2048 by 1536 pixels — 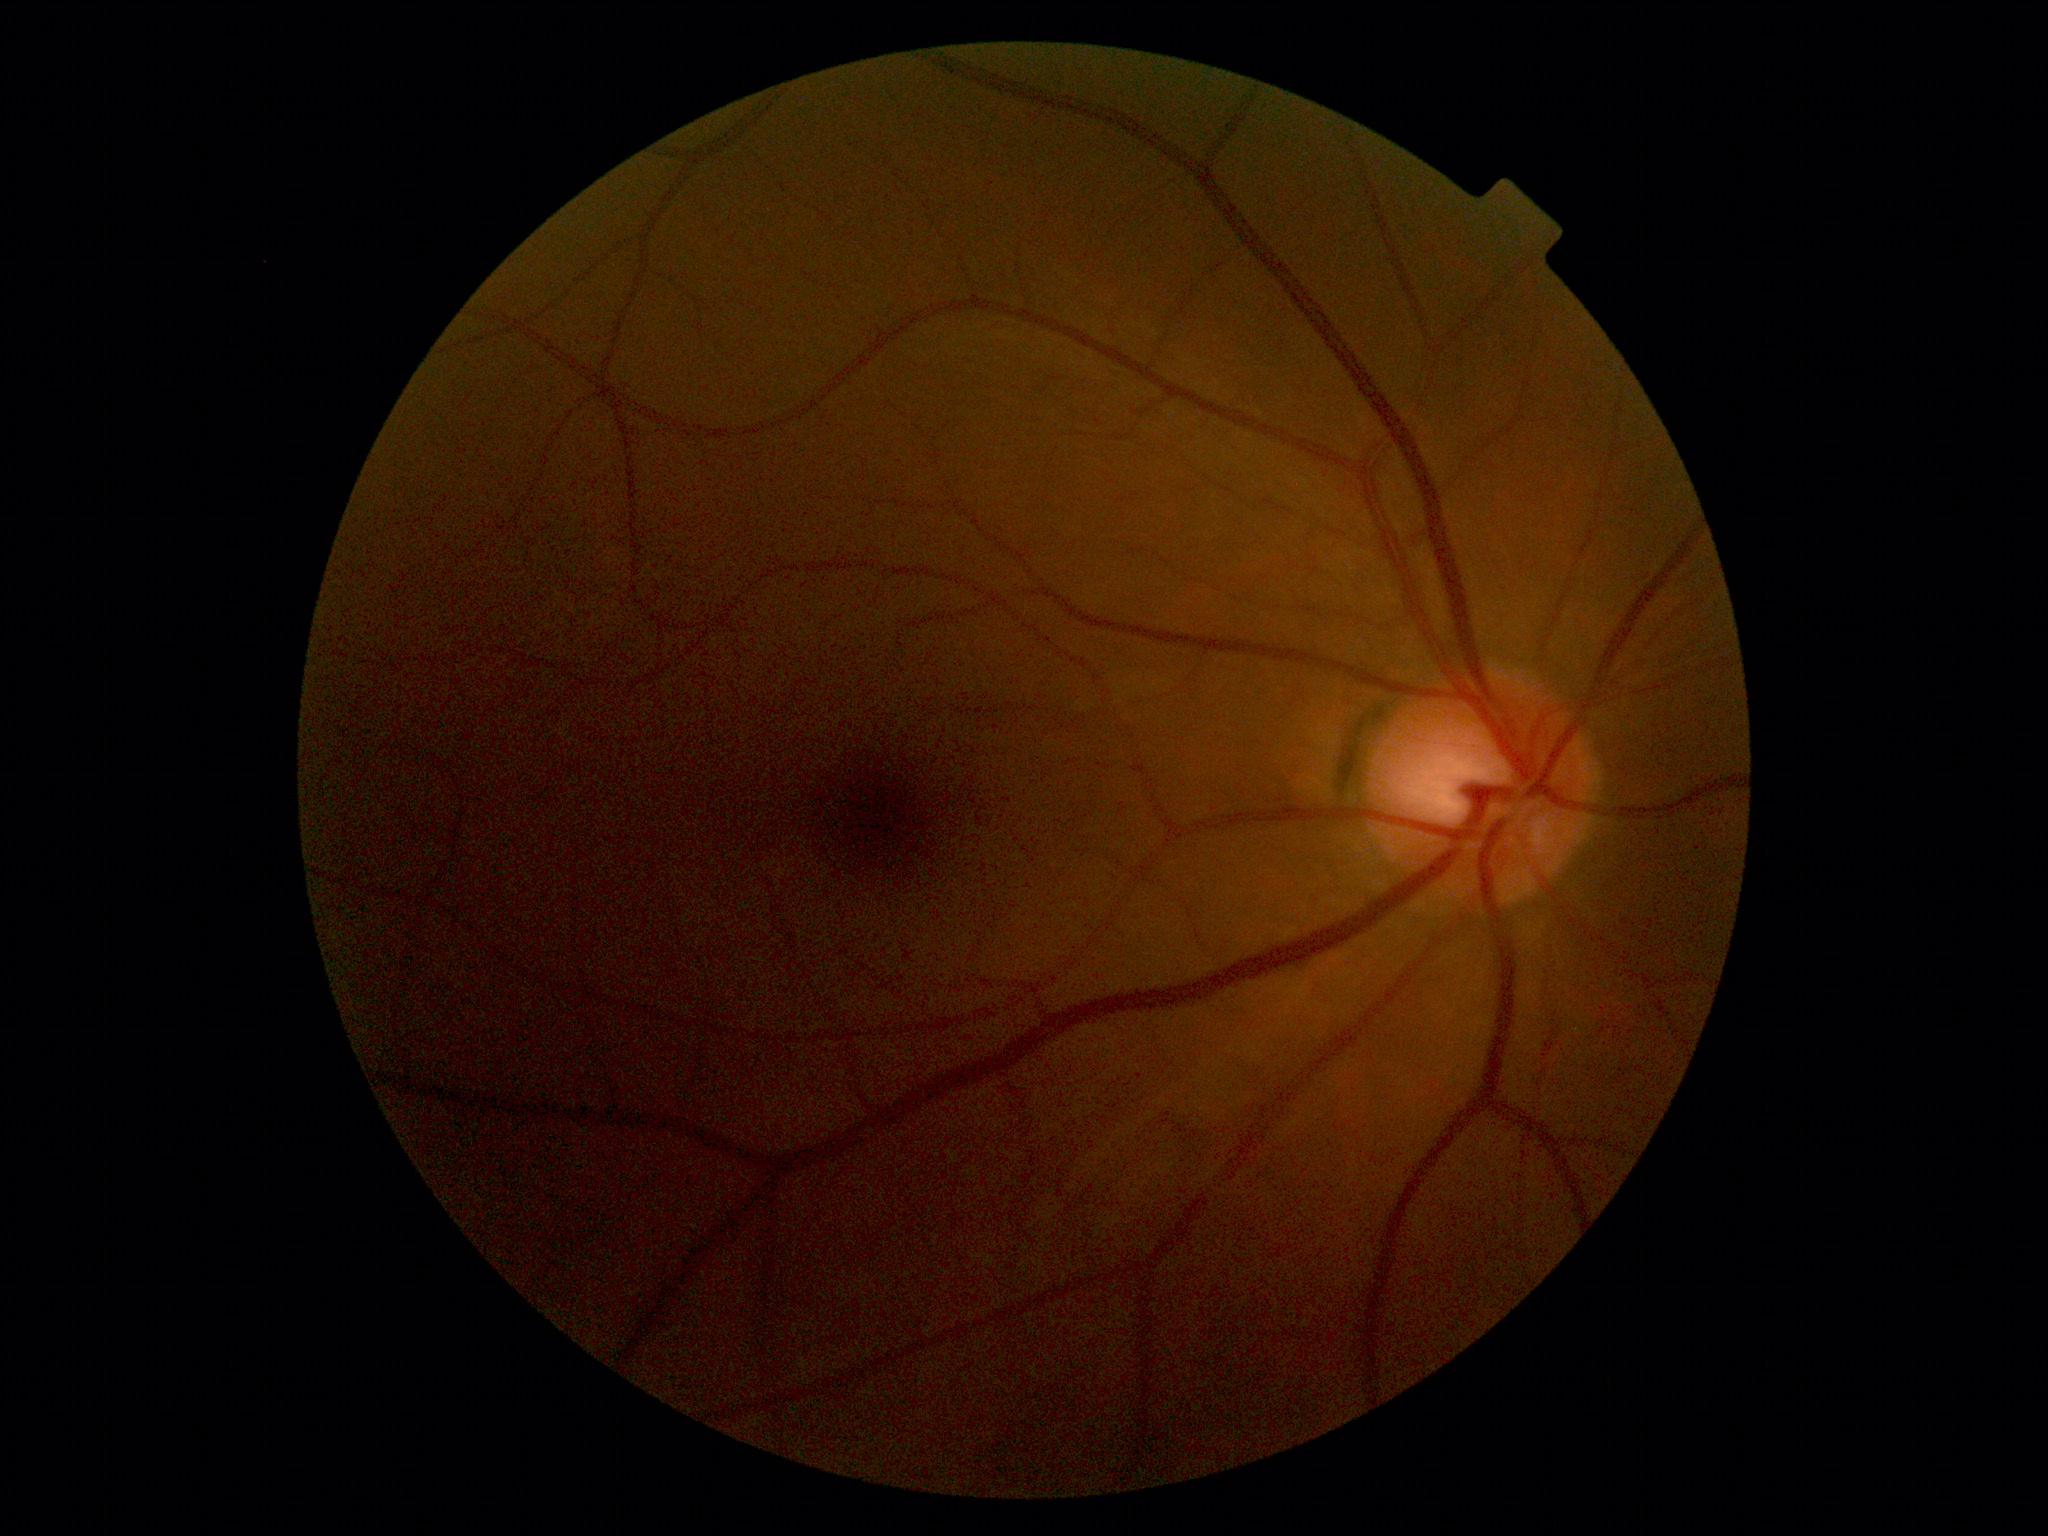

DR severity: 0/4.